Camera: Remidio Fundus on Phone, CFP, 1659x2212px: 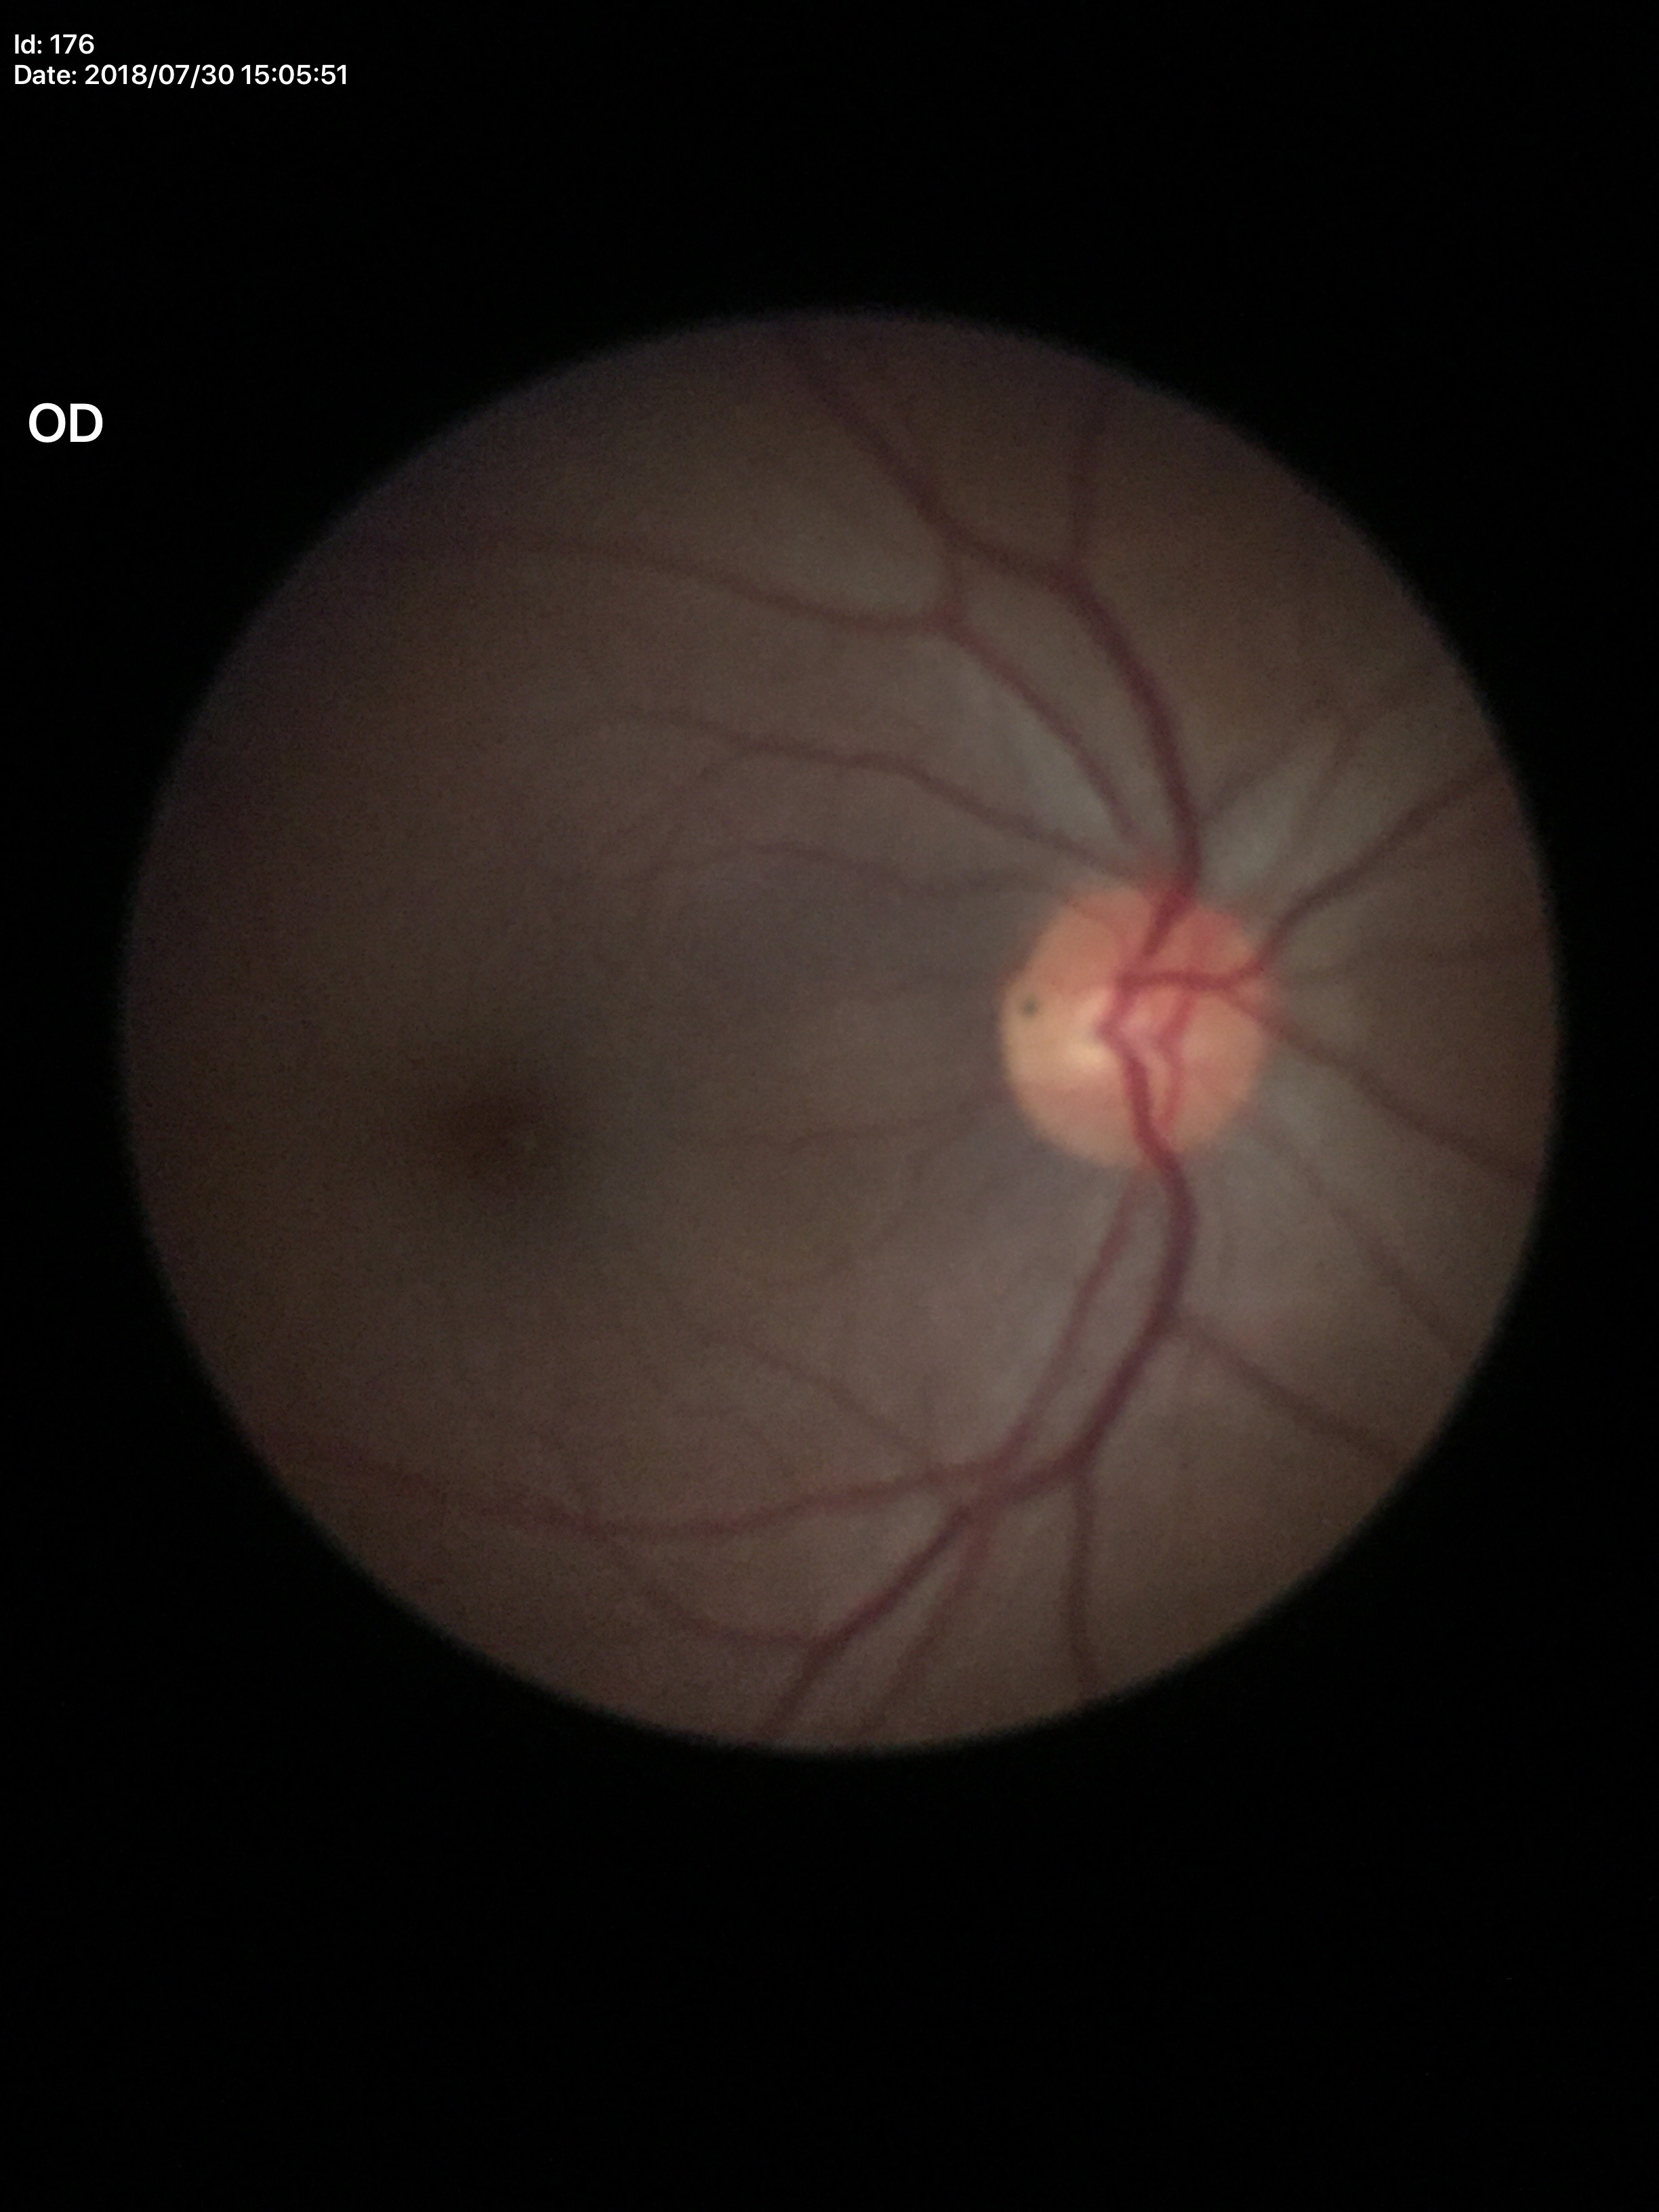 {"vcdr": "0.41", "glaucoma_decision": "negative (all 5 graders called normal)", "hcdr": "0.51"}